1932x1932; 45° FOV; retinal fundus photograph: 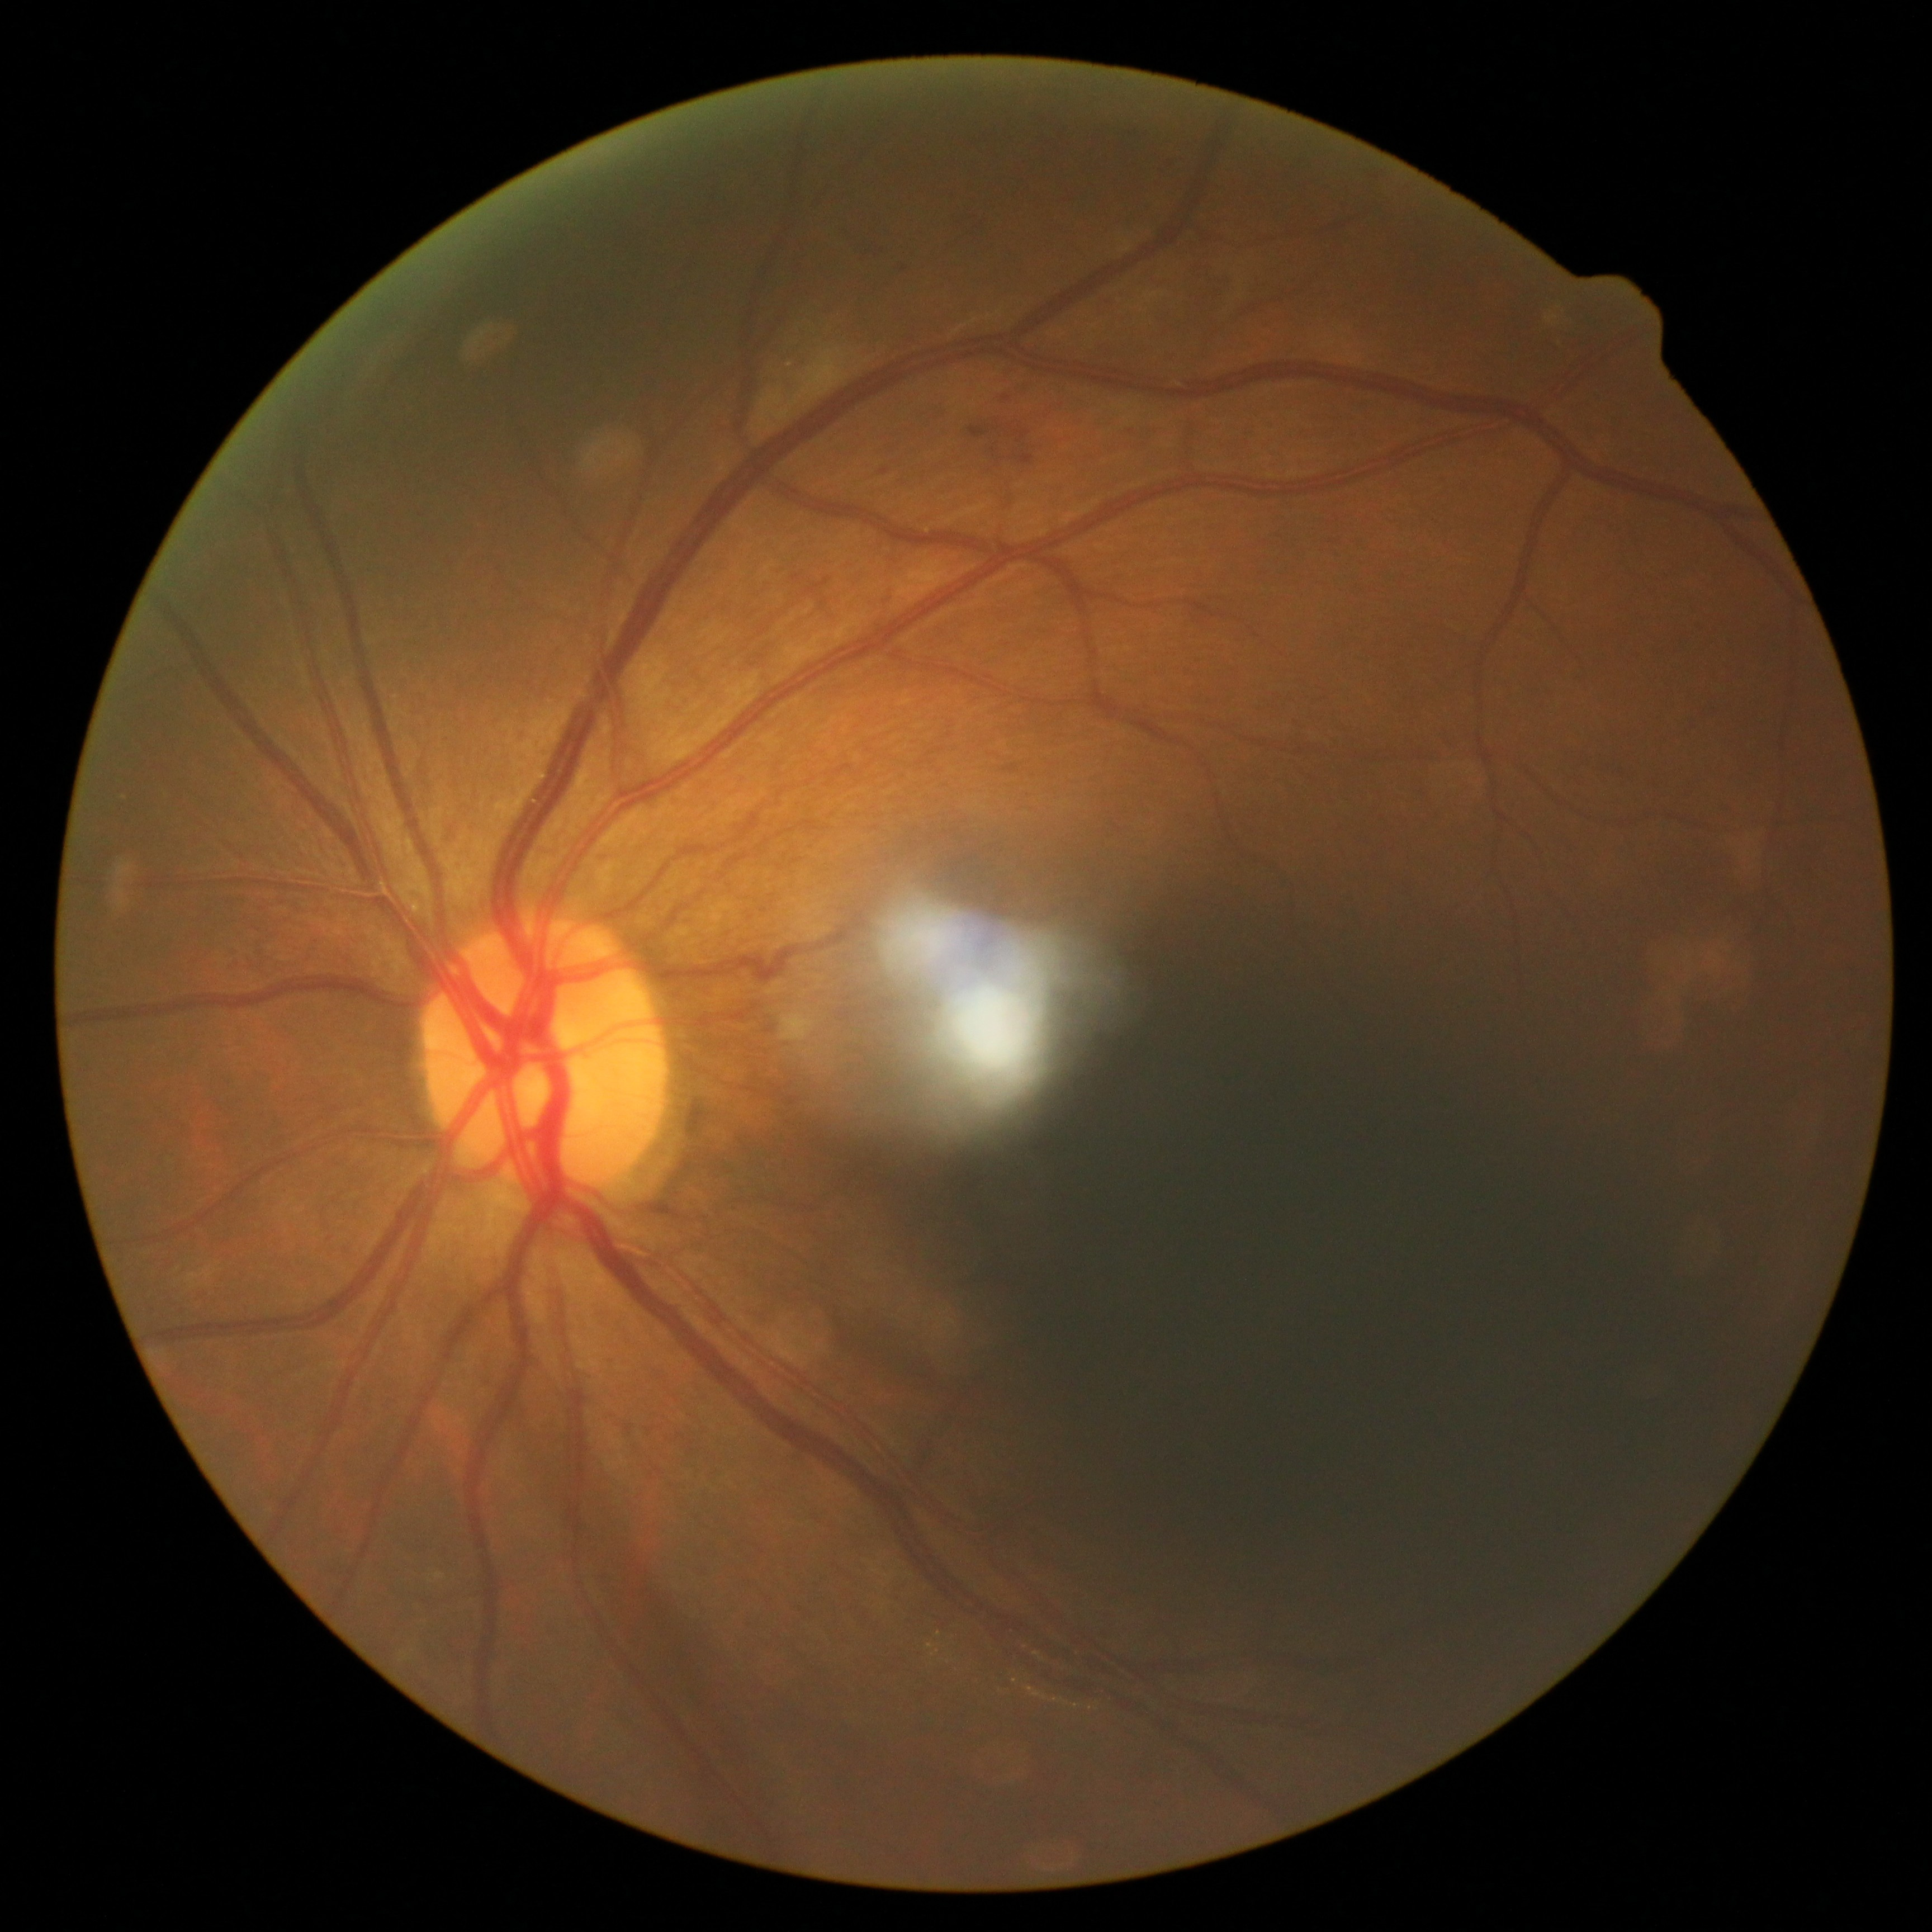

DR: grade 2.